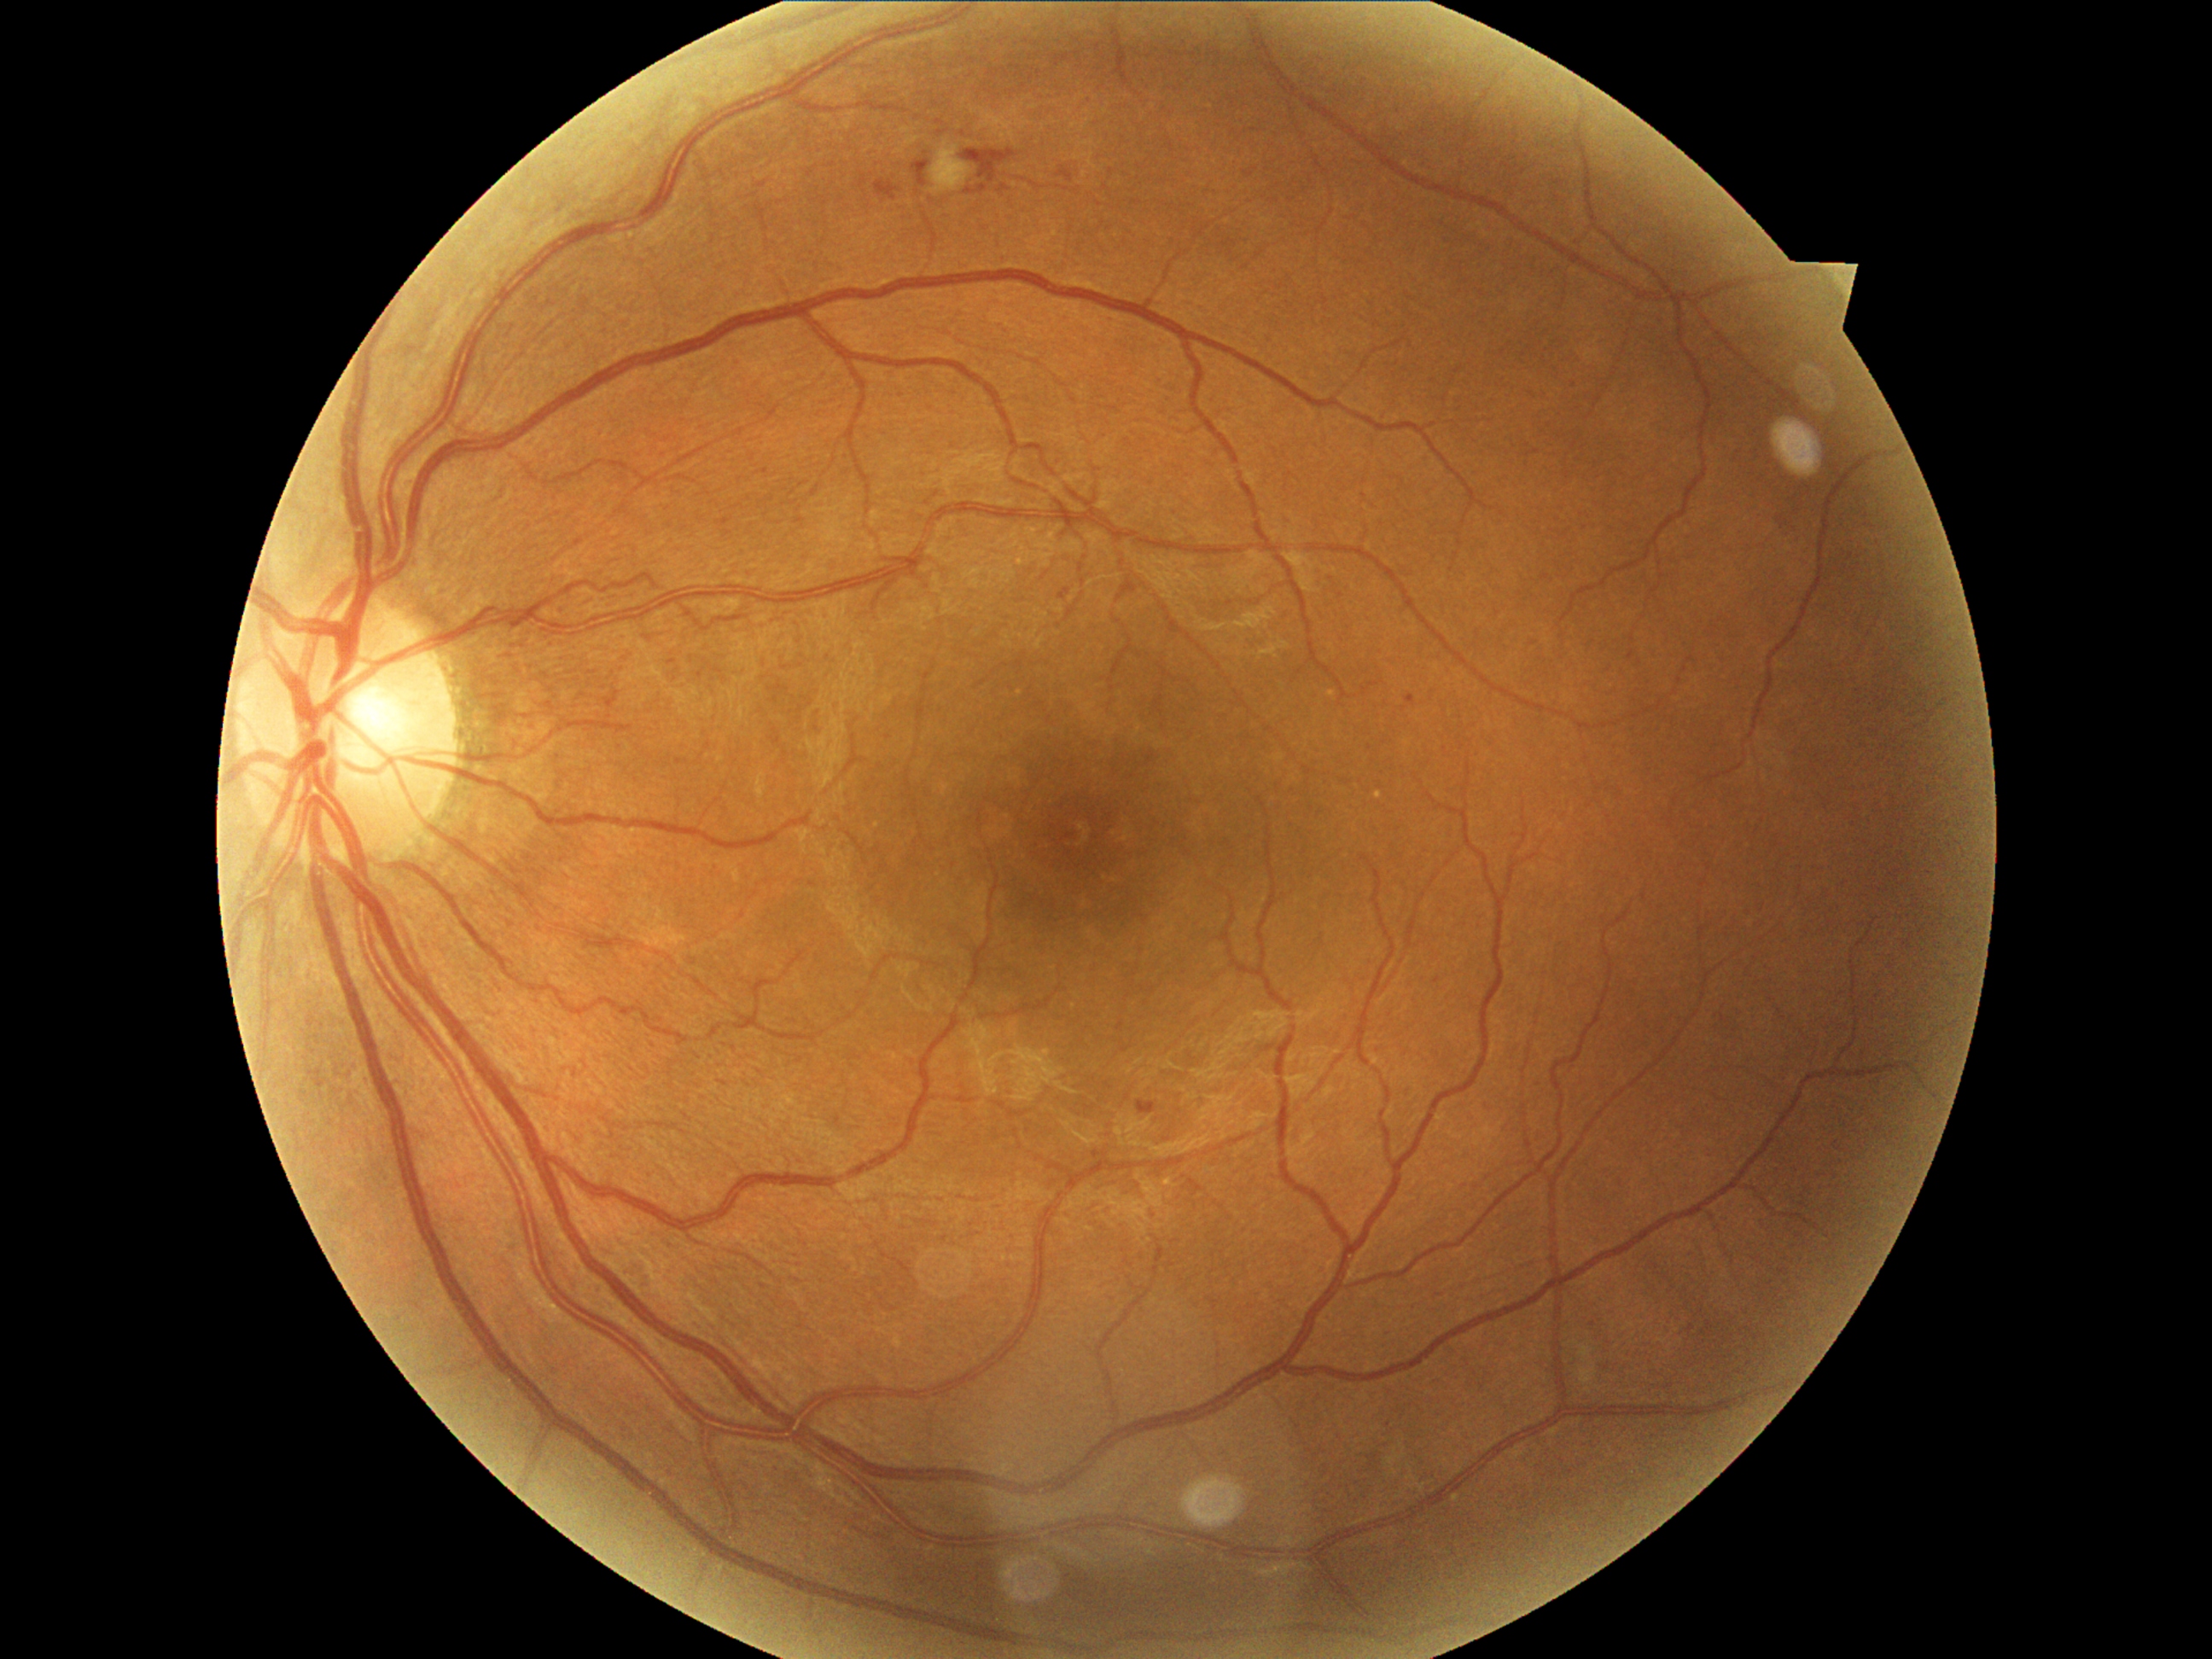 DR class: non-proliferative diabetic retinopathy.
DR severity: moderate non-proliferative diabetic retinopathy (grade 2).